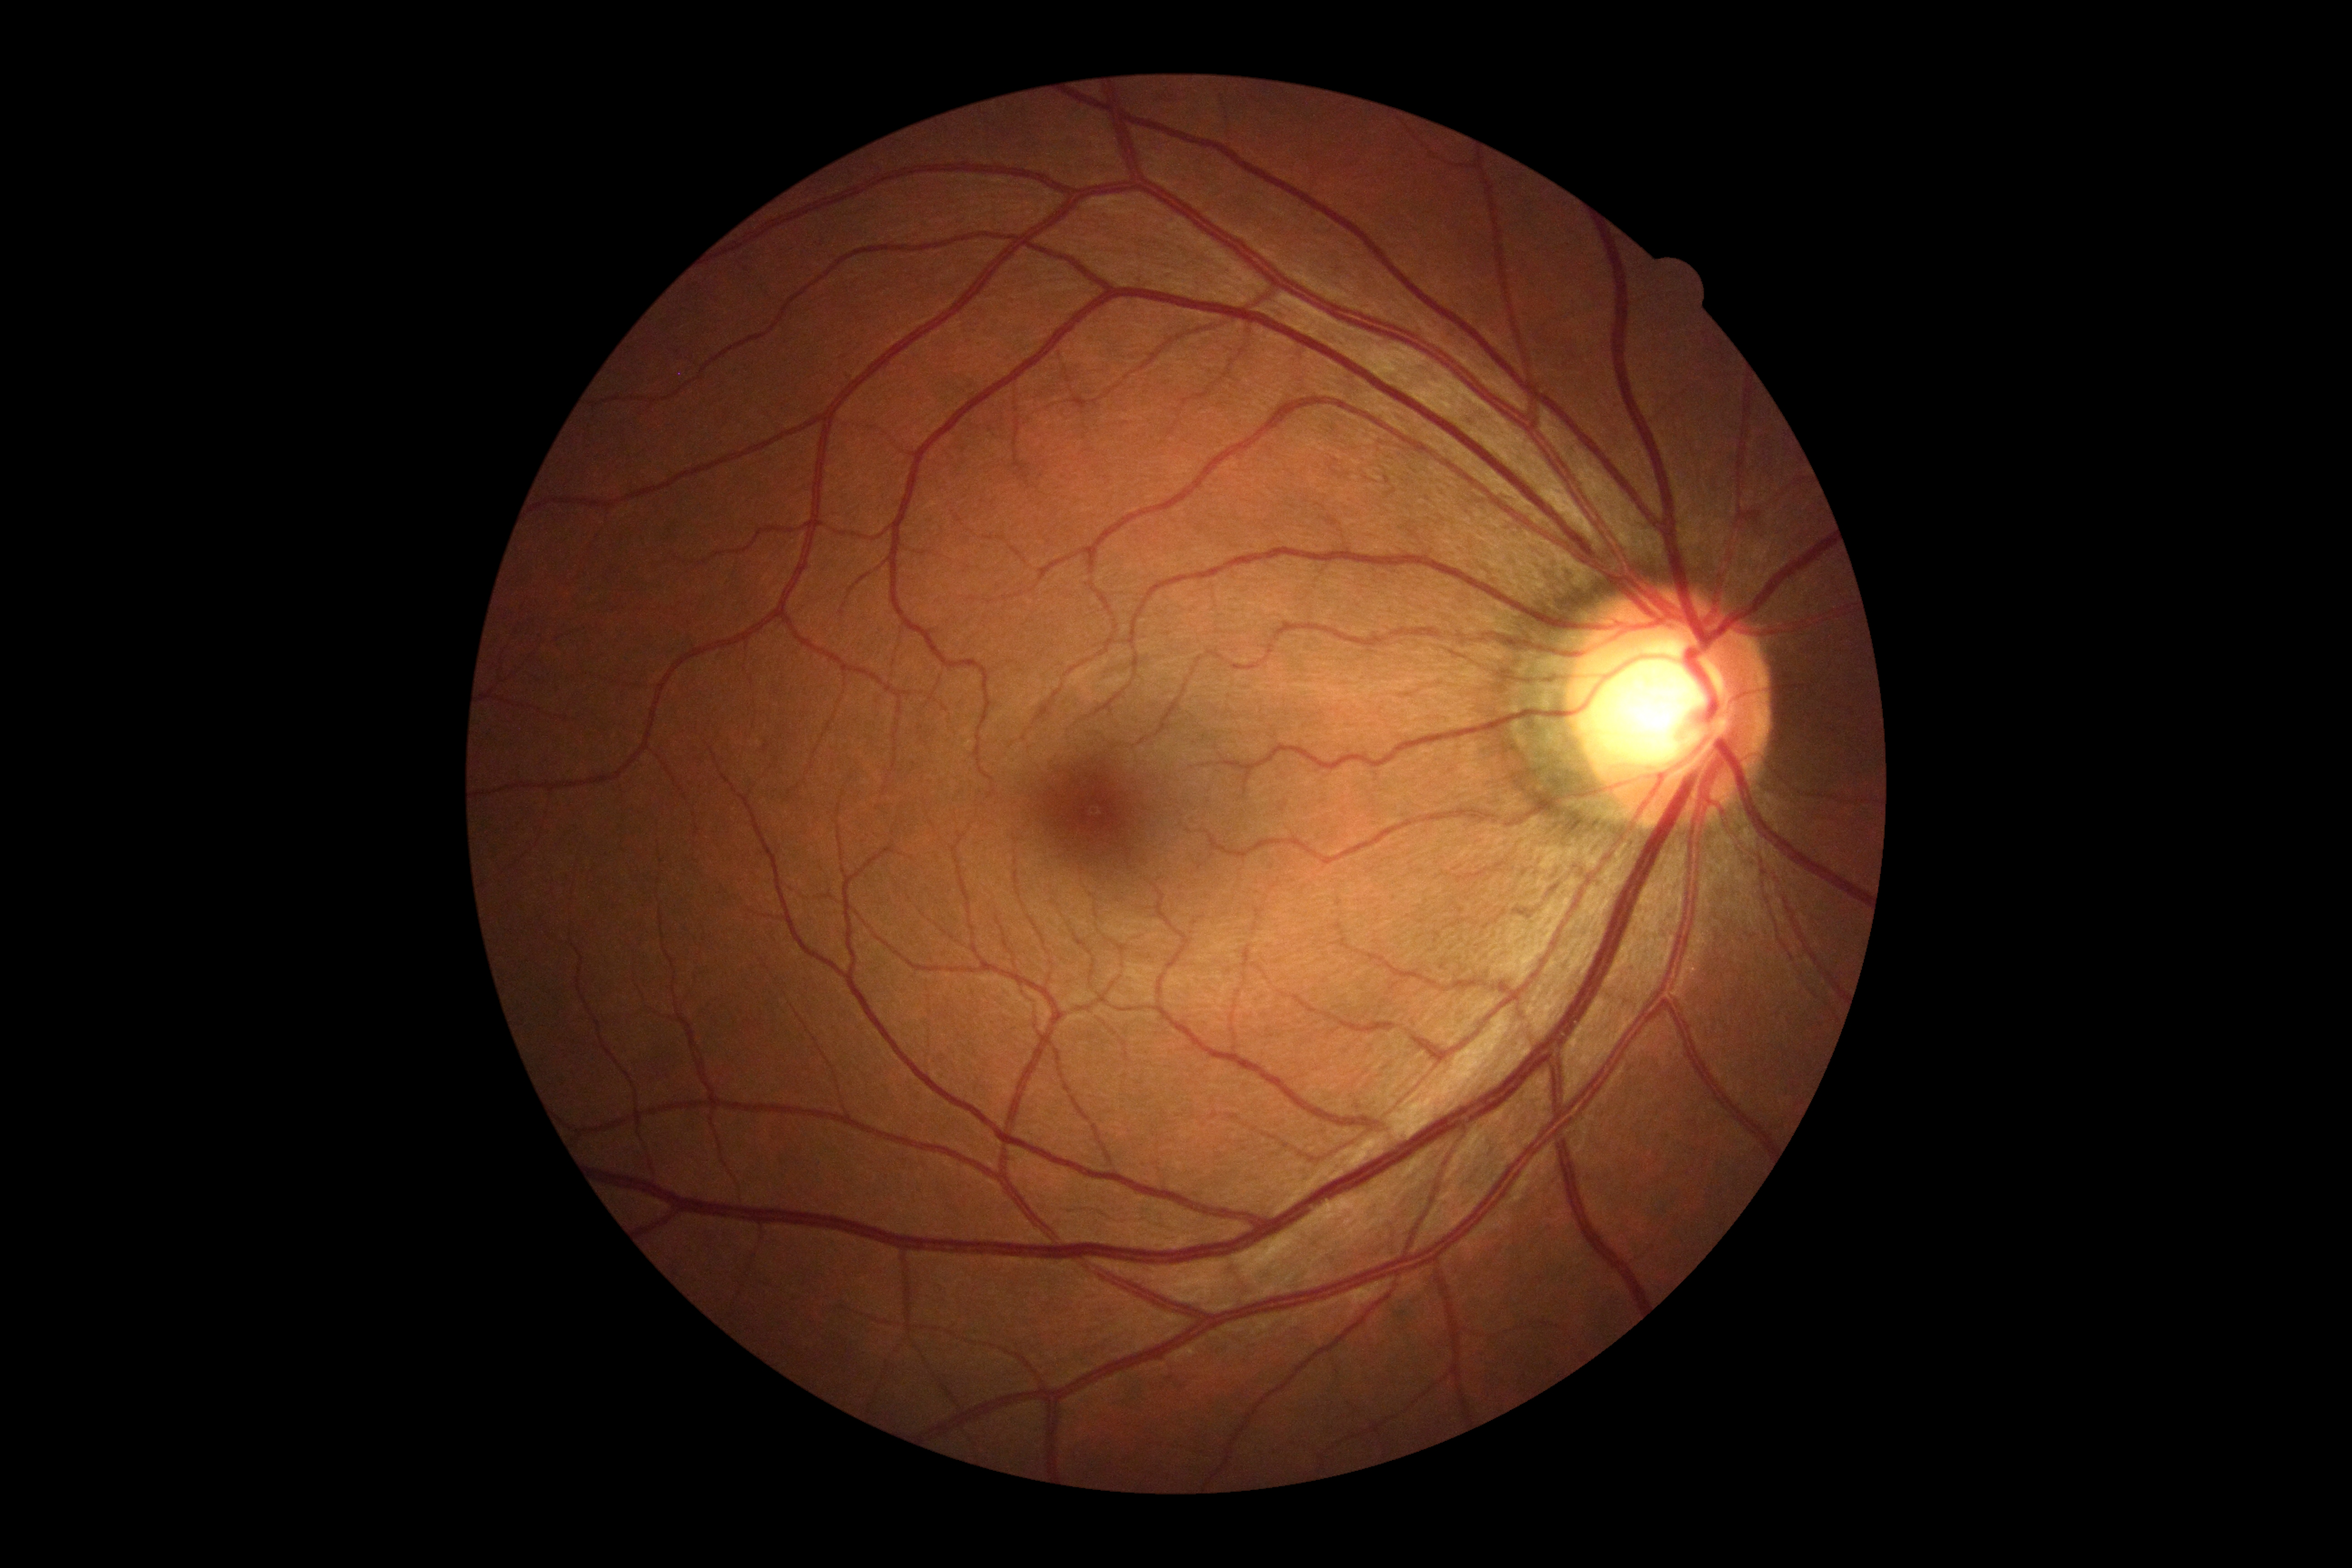 DR: grade 0 (no apparent retinopathy).